Modified Davis grading:
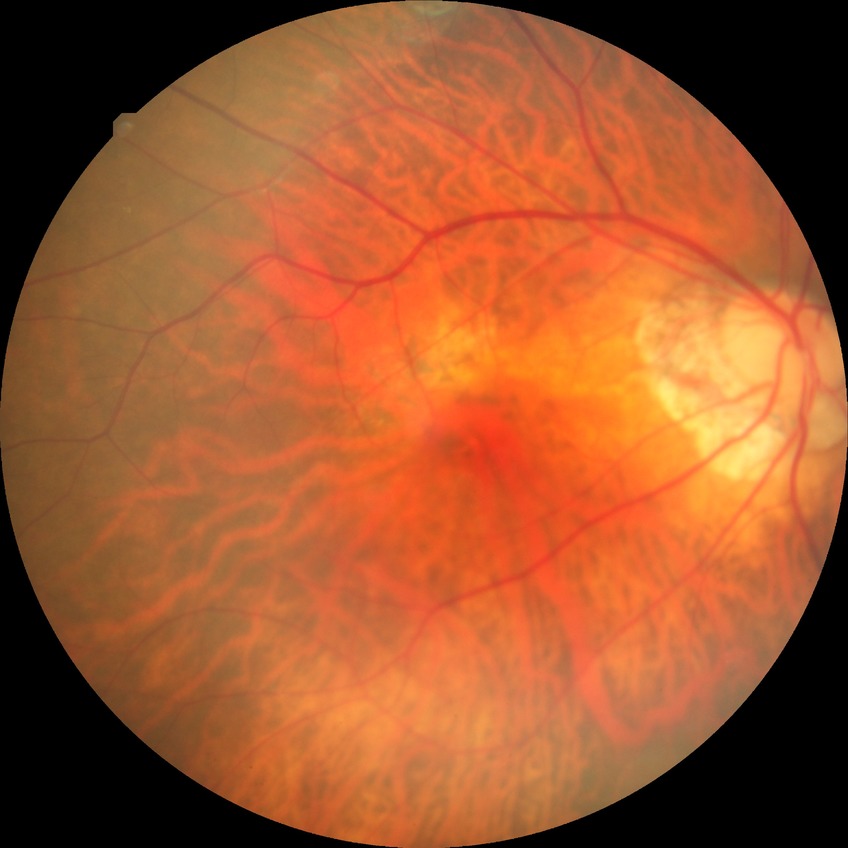 Diabetic retinopathy (DR) is no diabetic retinopathy (NDR).